Retinal fundus photograph: 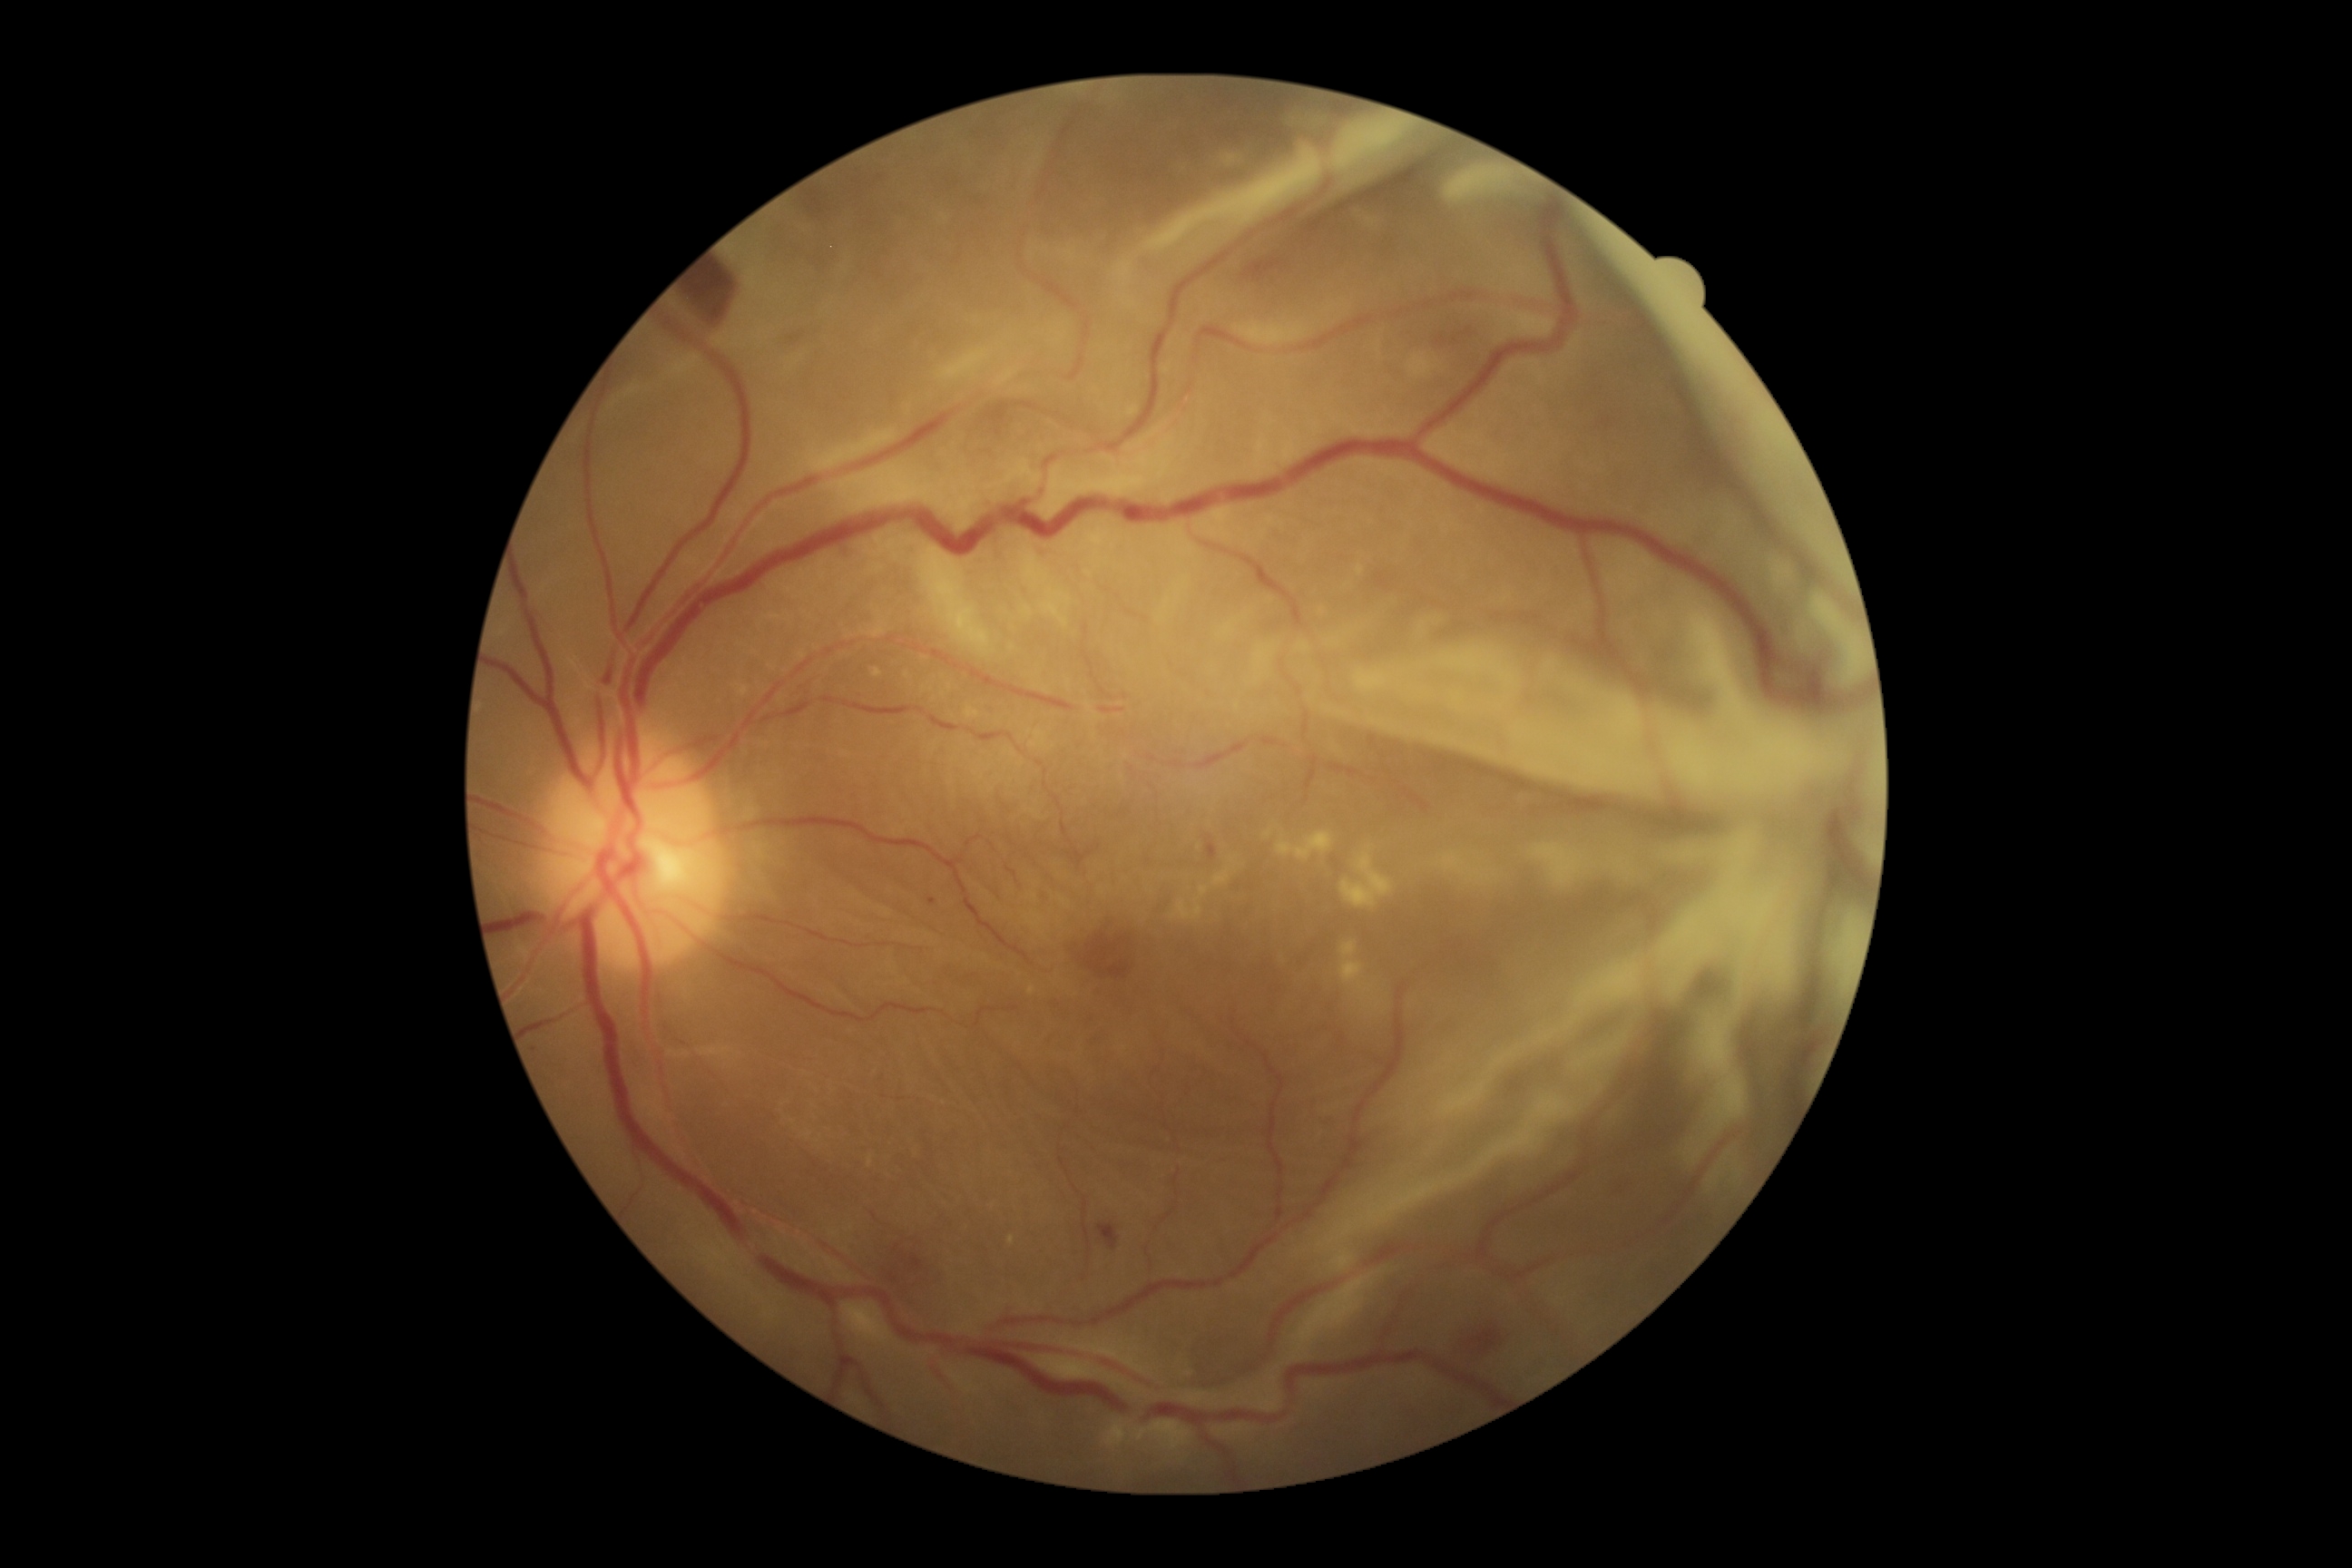

DR grade is PDR (4).